Nonmydriatic fundus photograph:
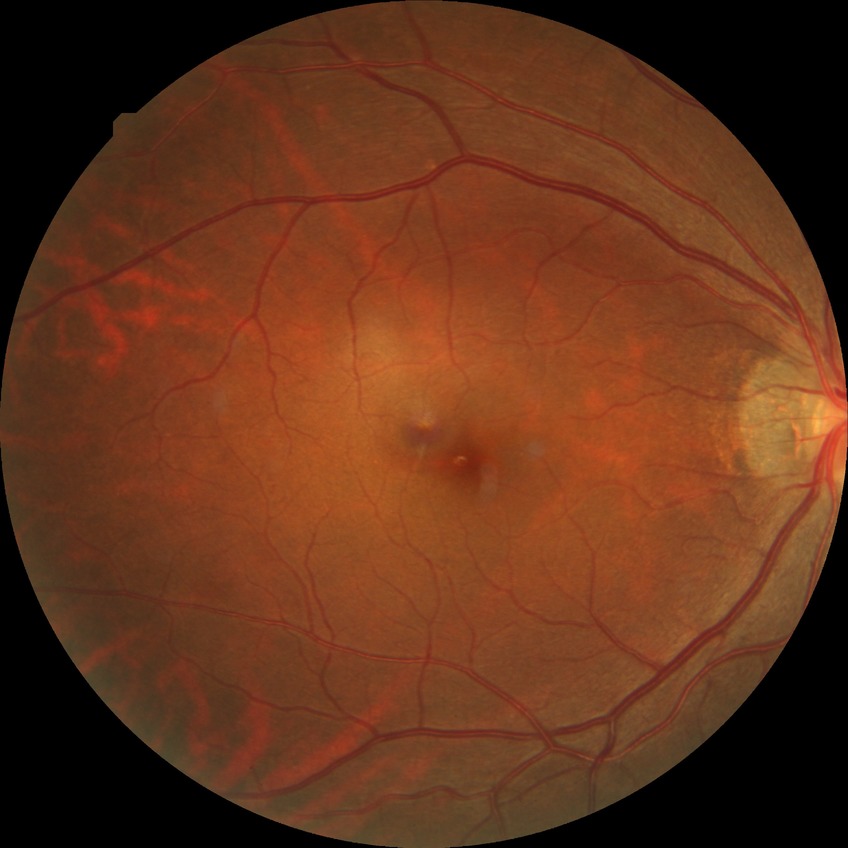

DR stage is SDR.